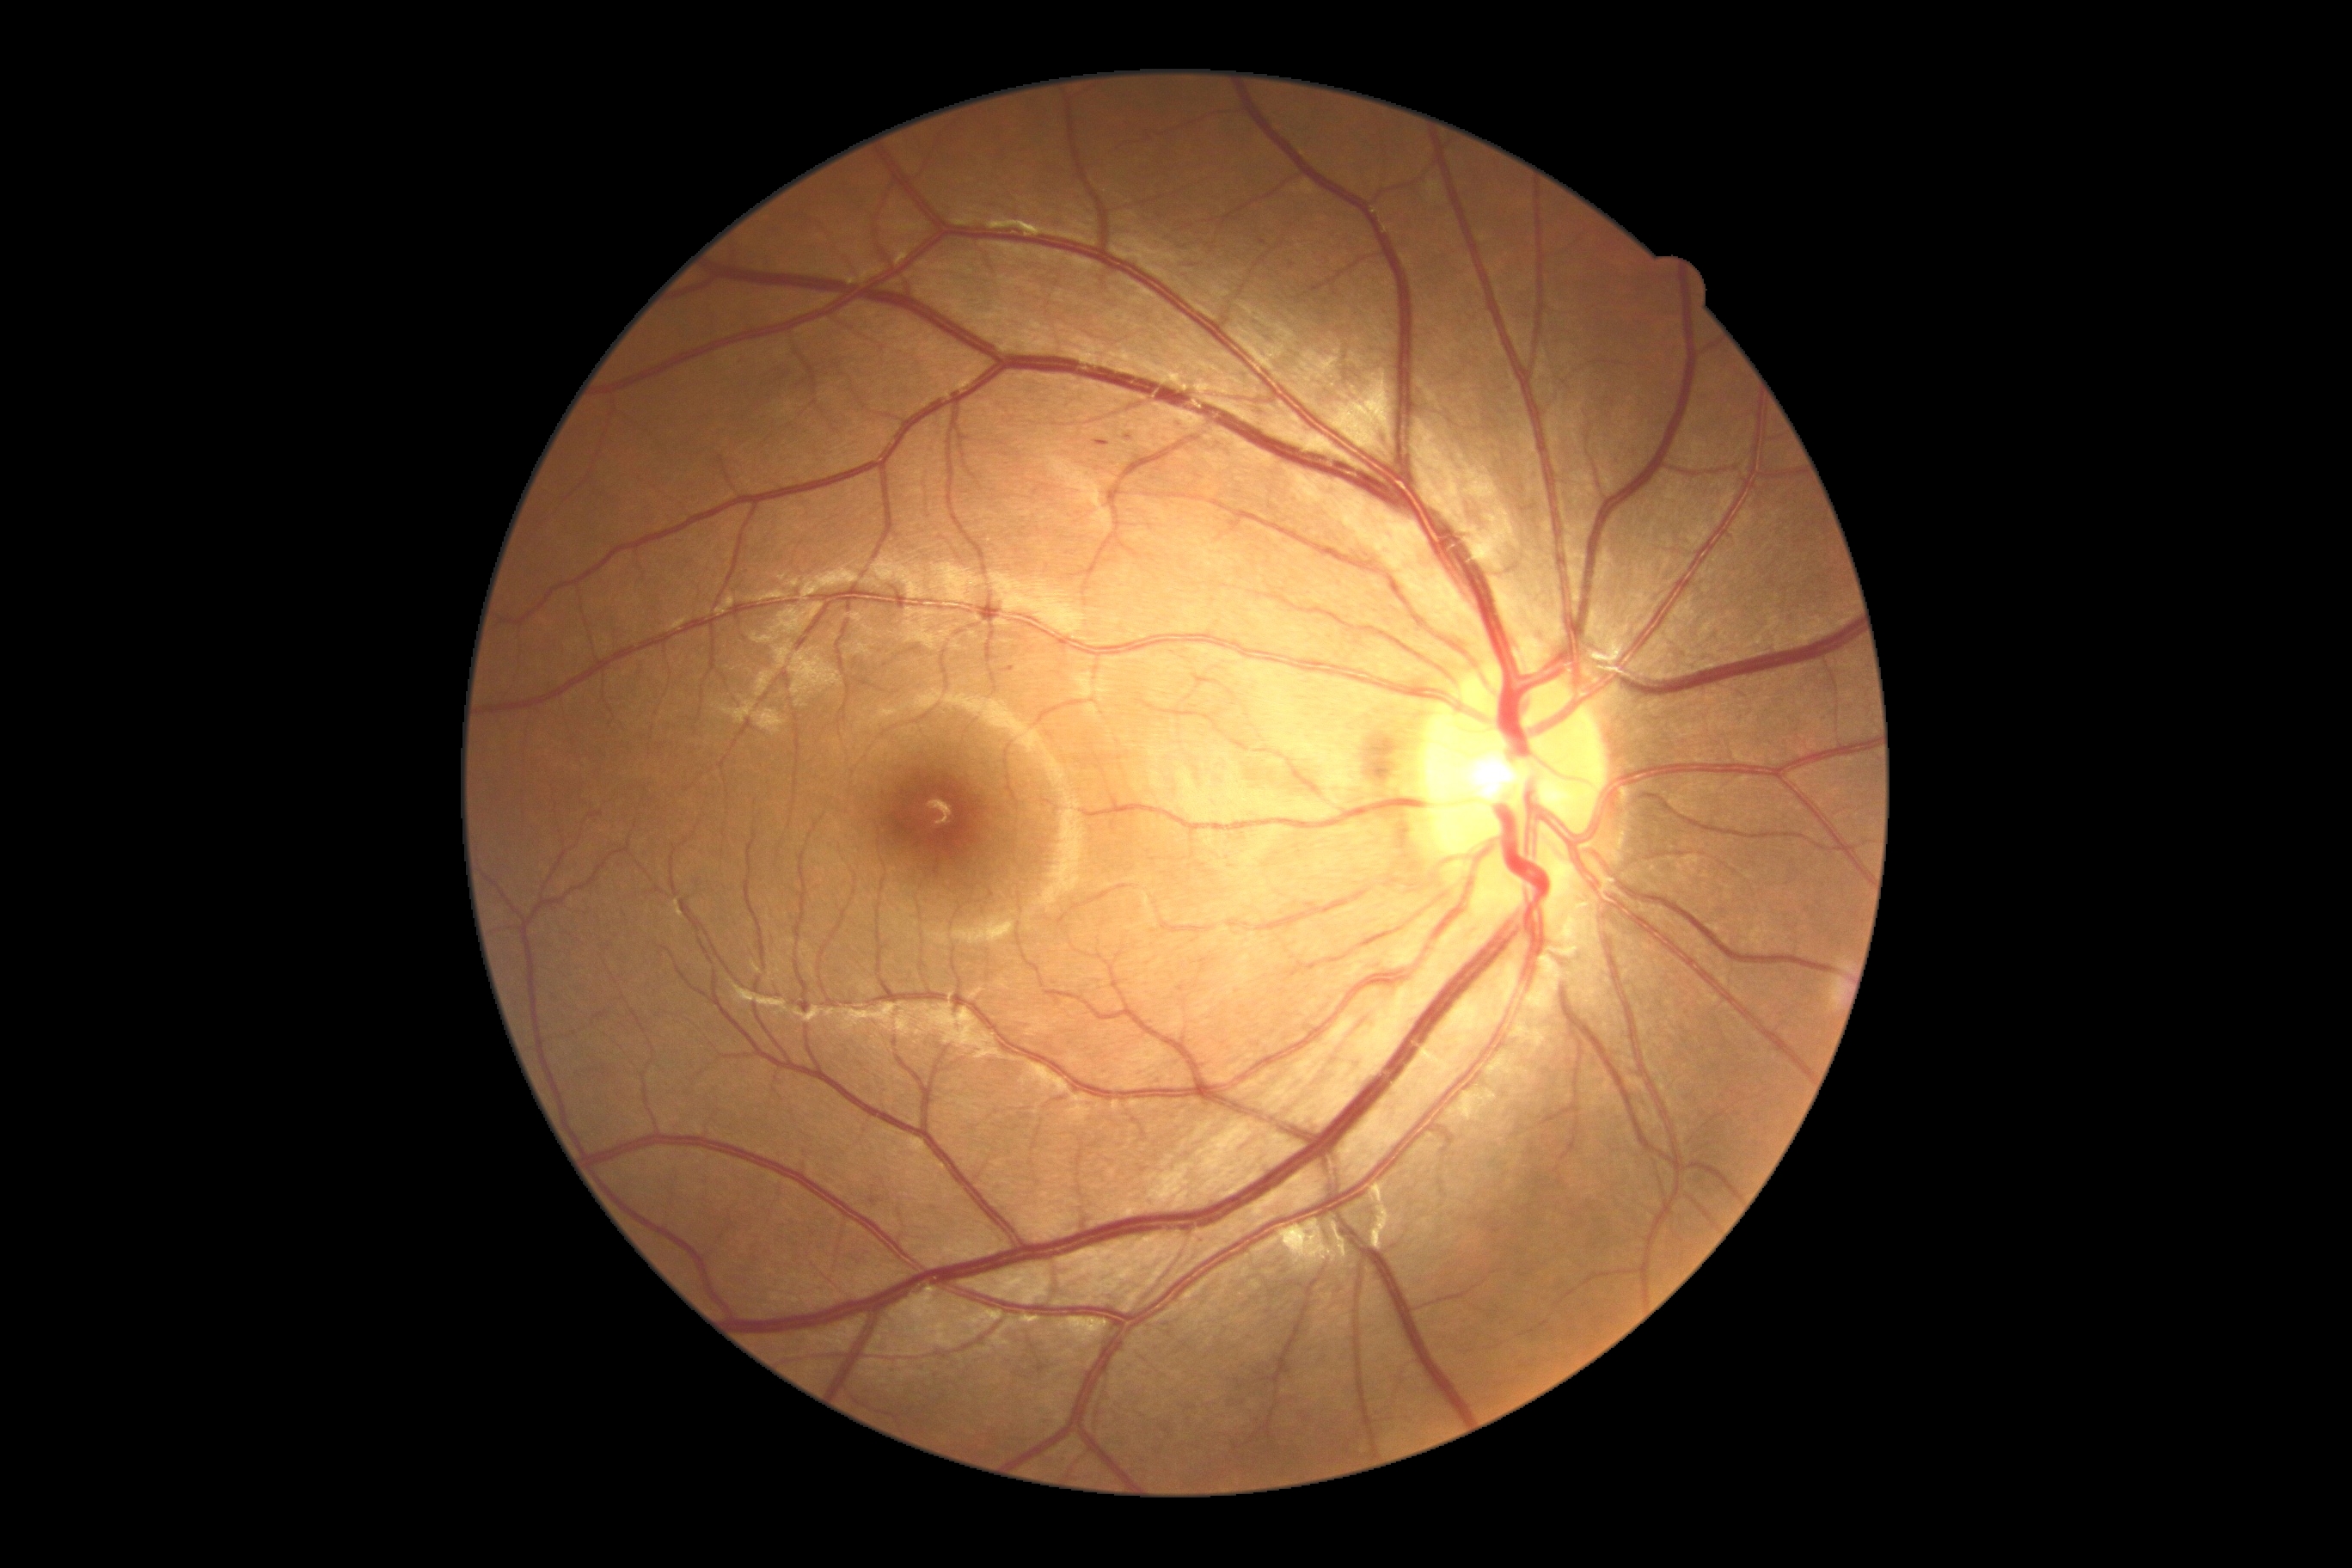
<lesions>
  <dr_grade>1</dr_grade>
  <se />
  <he />
  <ex />
  <ma>[1001, 666, 1015, 673] | [1094, 439, 1110, 446]</ma>
  <ma_small>(1128,438) | (1292,265)</ma_small>
</lesions>